100° field of view (Phoenix ICON) · infant wide-field retinal image · 1240 by 1240 pixels:
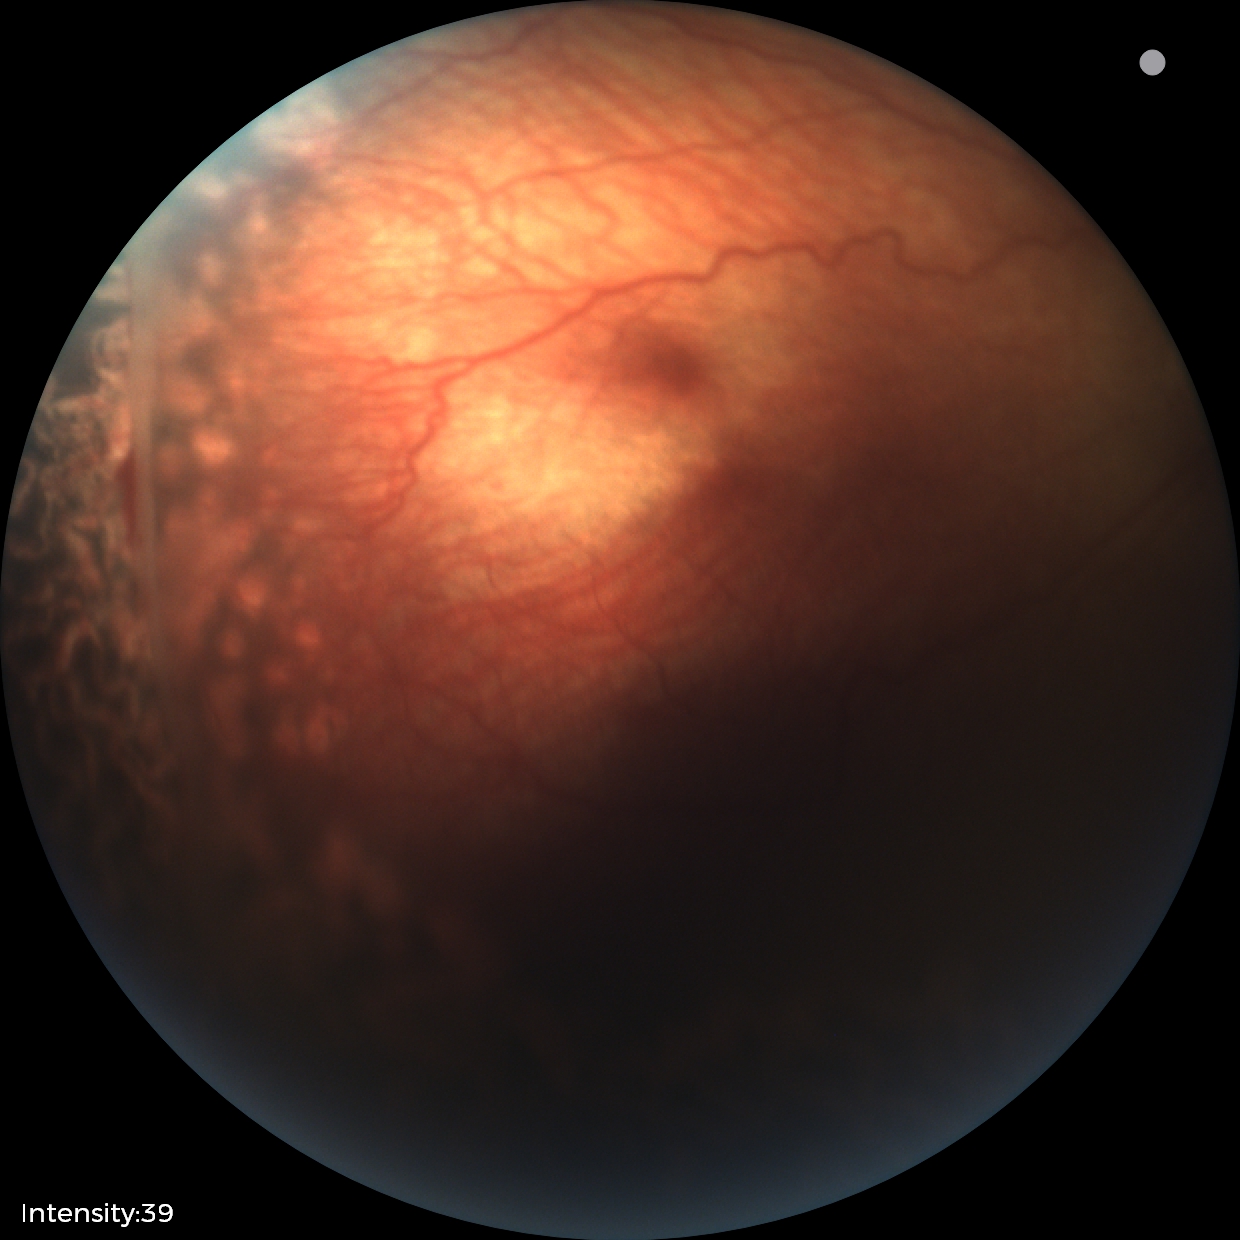

Diagnosis from this screening exam: status post retinopathy of prematurity.